Wide-field fundus photograph from neonatal ROP screening:
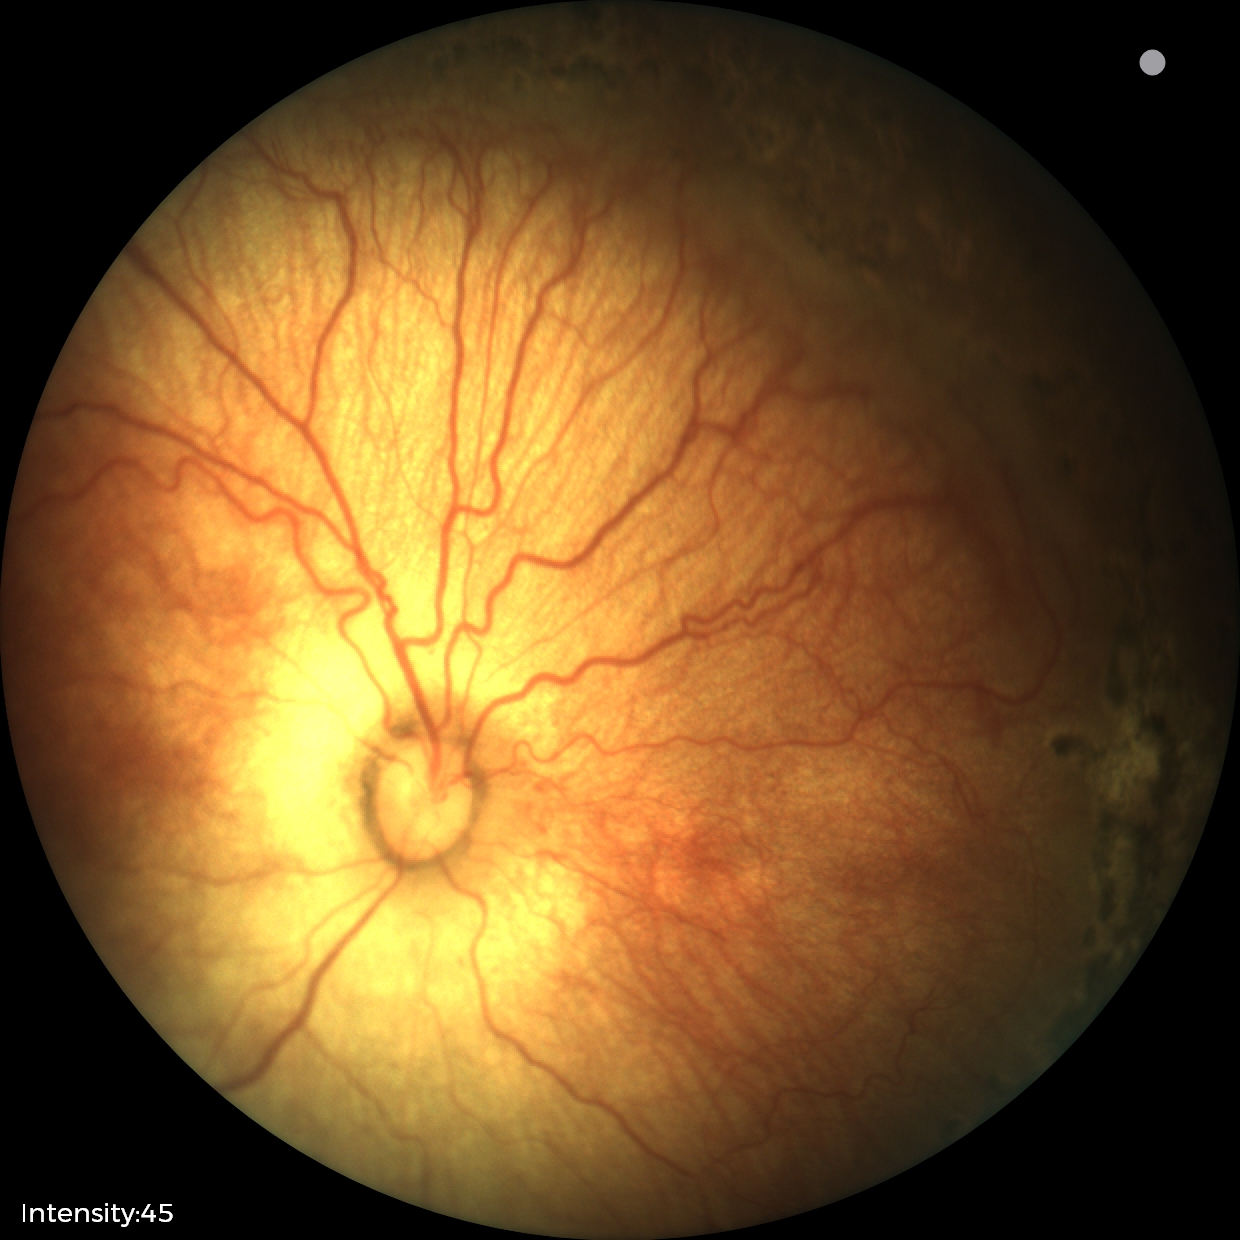 Without plus disease.
From an examination with diagnosis of status post retinopathy of prematurity.